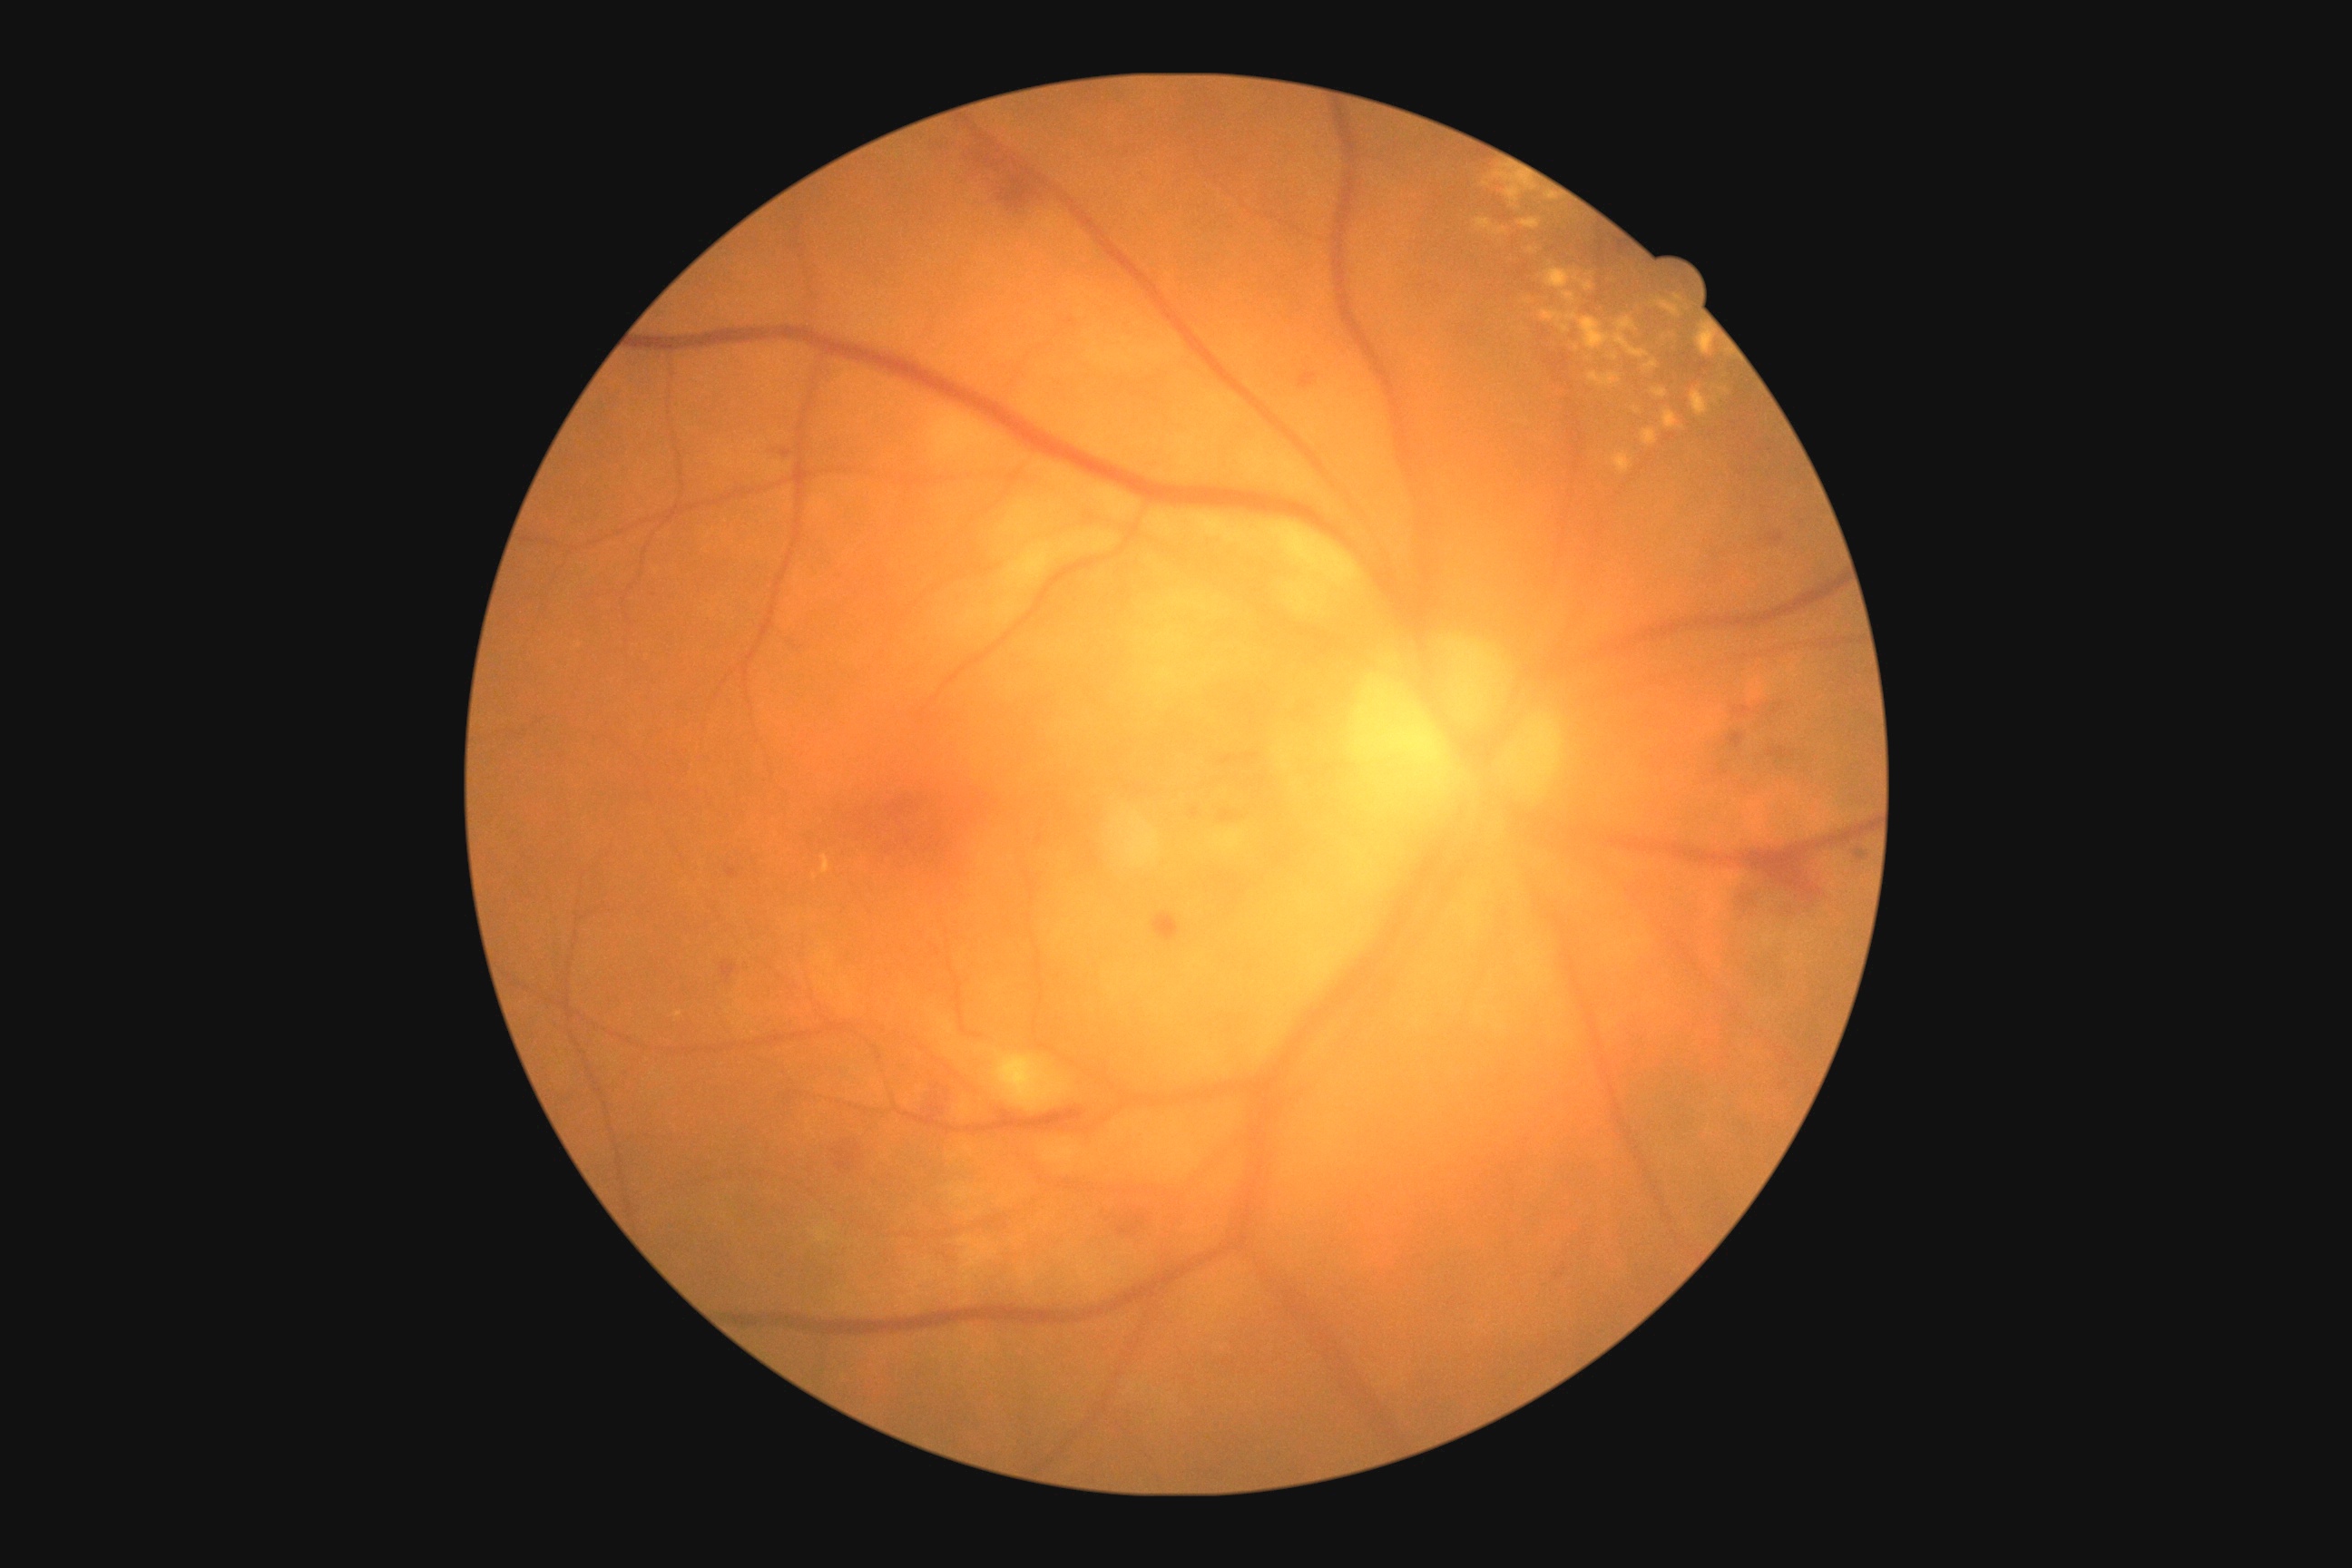

dr_grade: 2/4